Fundus photo · DR severity per modified Davis staging · camera: NIDEK AFC-230
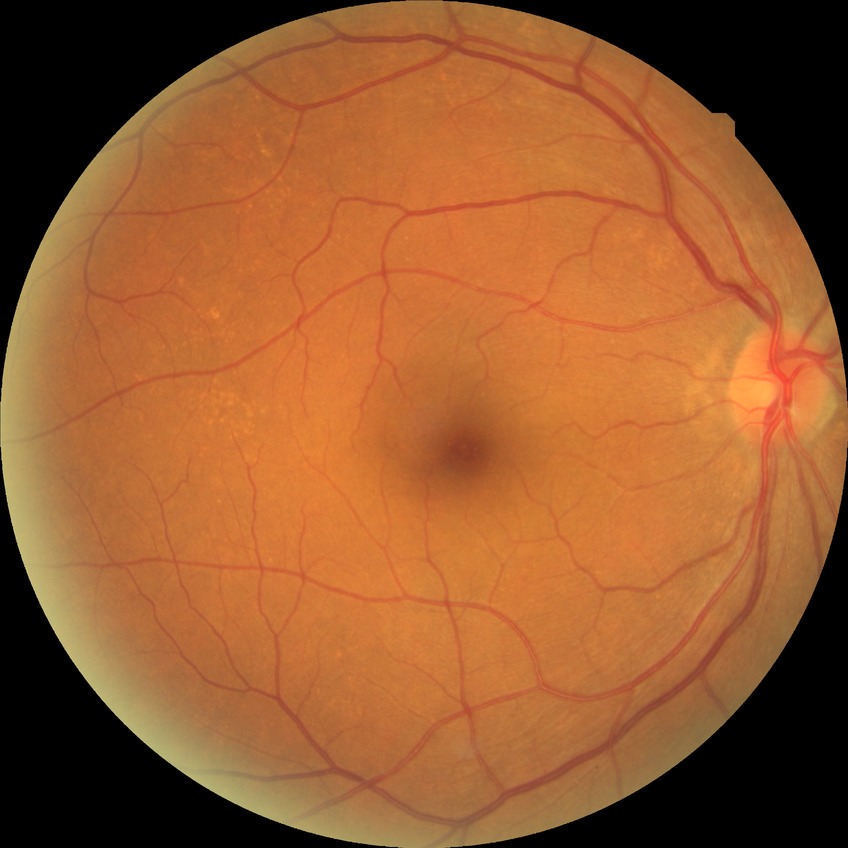
DR grade: NDR.